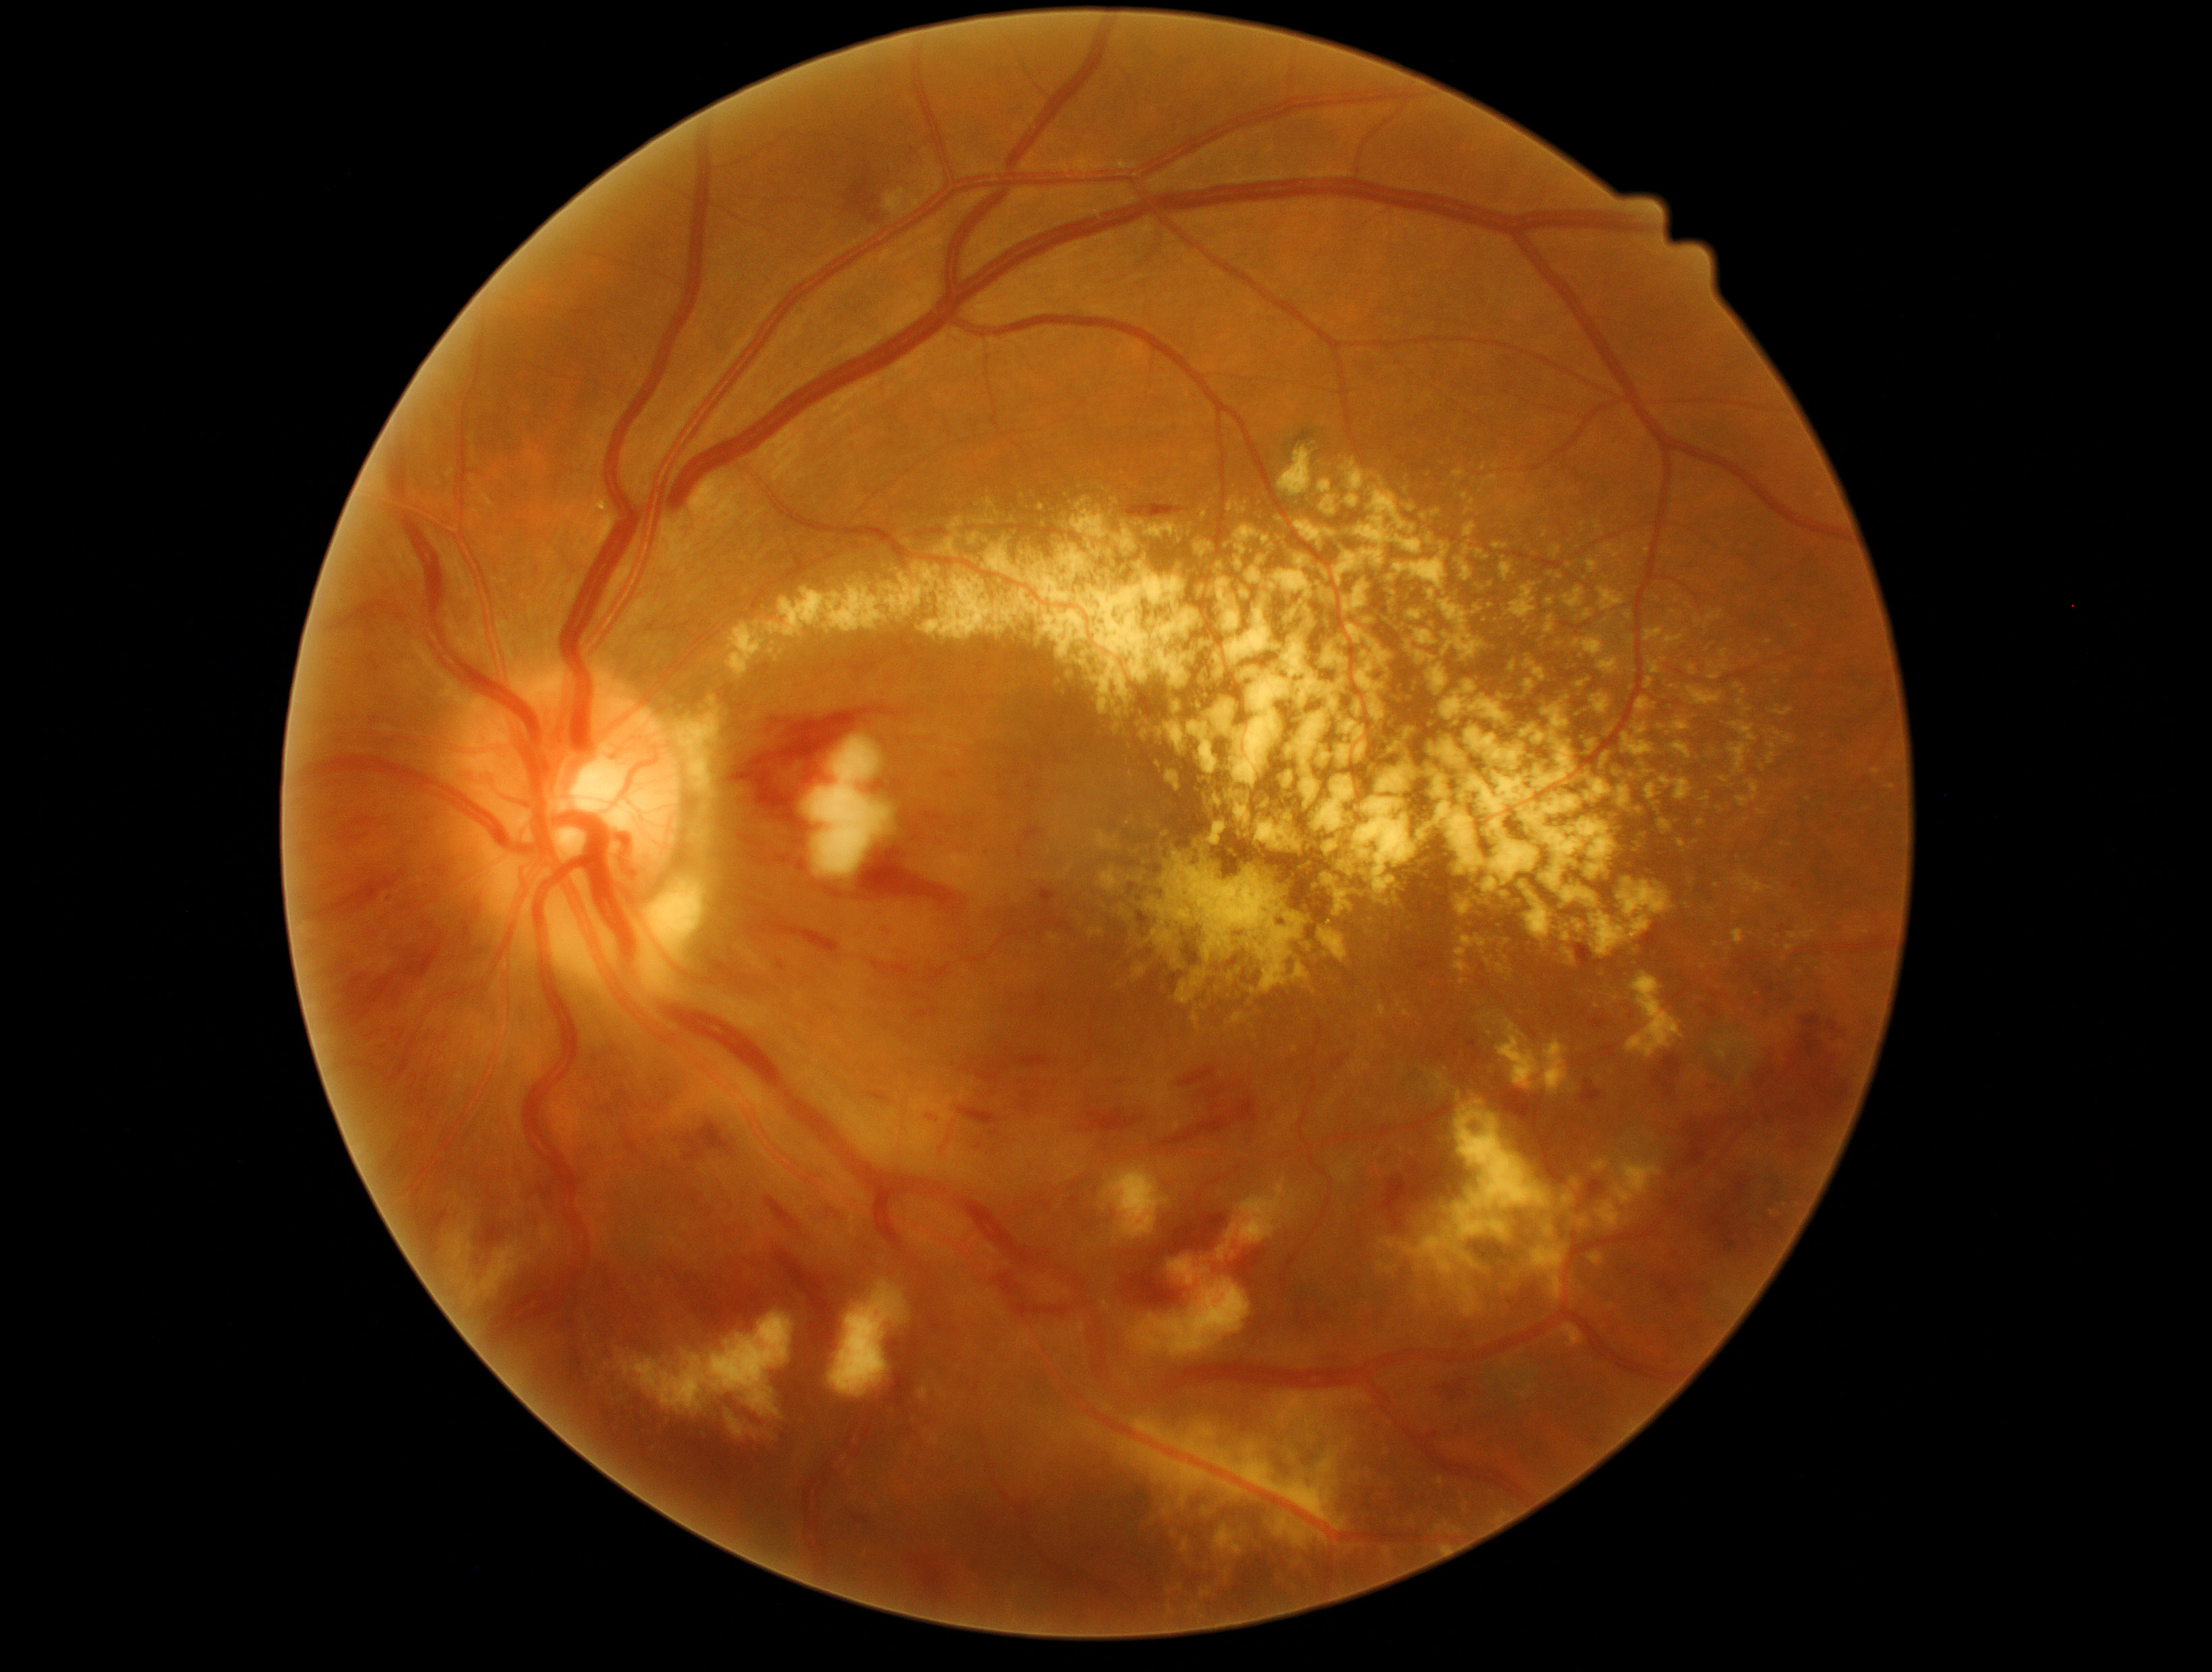
partial: true
dr_grade: 3
lesions:
  he:
    - x1=737, y1=896, x2=759, y2=909
    - x1=1673, y1=1166, x2=1679, y2=1174
    - x1=1588, y1=1429, x2=1602, y2=1446
    - x1=1680, y1=1283, x2=1699, y2=1292
    - x1=1761, y1=1176, x2=1784, y2=1228
    - x1=1016, y1=1090, x2=1039, y2=1114
    - x1=771, y1=853, x2=809, y2=873
    - x1=617, y1=1101, x2=624, y2=1112
    - x1=1159, y1=1094, x2=1259, y2=1155
    - x1=1691, y1=1323, x2=1700, y2=1337
    - x1=1575, y1=950, x2=1617, y2=982
    - x1=1122, y1=1212, x2=1229, y2=1310
    - x1=1827, y1=1020, x2=1847, y2=1038
    - x1=1180, y1=1067, x2=1229, y2=1100
    - x1=740, y1=835, x2=765, y2=854
    - x1=1731, y1=957, x2=1795, y2=1004
    - x1=685, y1=1121, x2=737, y2=1160
    - x1=1641, y1=924, x2=1666, y2=961
  he_small_approx:
    - pt(1578, 947)
  ex:
    - x1=1448, y1=467, x2=1468, y2=482
    - x1=1406, y1=644, x2=1451, y2=696
    - x1=1733, y1=795, x2=1743, y2=806
    - x1=1595, y1=659, x2=1619, y2=683
    - x1=1428, y1=1070, x2=1452, y2=1092
    - x1=1093, y1=822, x2=1320, y2=1008
    - x1=1371, y1=1042, x2=1376, y2=1050
    - x1=1592, y1=1159, x2=1611, y2=1172
    - x1=1592, y1=520, x2=1599, y2=533
    - x1=1192, y1=551, x2=1240, y2=630
    - x1=1544, y1=691, x2=1572, y2=727
    - x1=1576, y1=706, x2=1587, y2=722
    - x1=1559, y1=874, x2=1675, y2=976
    - x1=1390, y1=675, x2=1416, y2=705
    - x1=1316, y1=926, x2=1352, y2=967
    - x1=1397, y1=1001, x2=1403, y2=1009
    - x1=949, y1=517, x2=964, y2=531
    - x1=1491, y1=1505, x2=1511, y2=1526
  ex_small_approx:
    - pt(1717, 886)
    - pt(1703, 967)